45° field of view; image size 1932x1910; CFP.
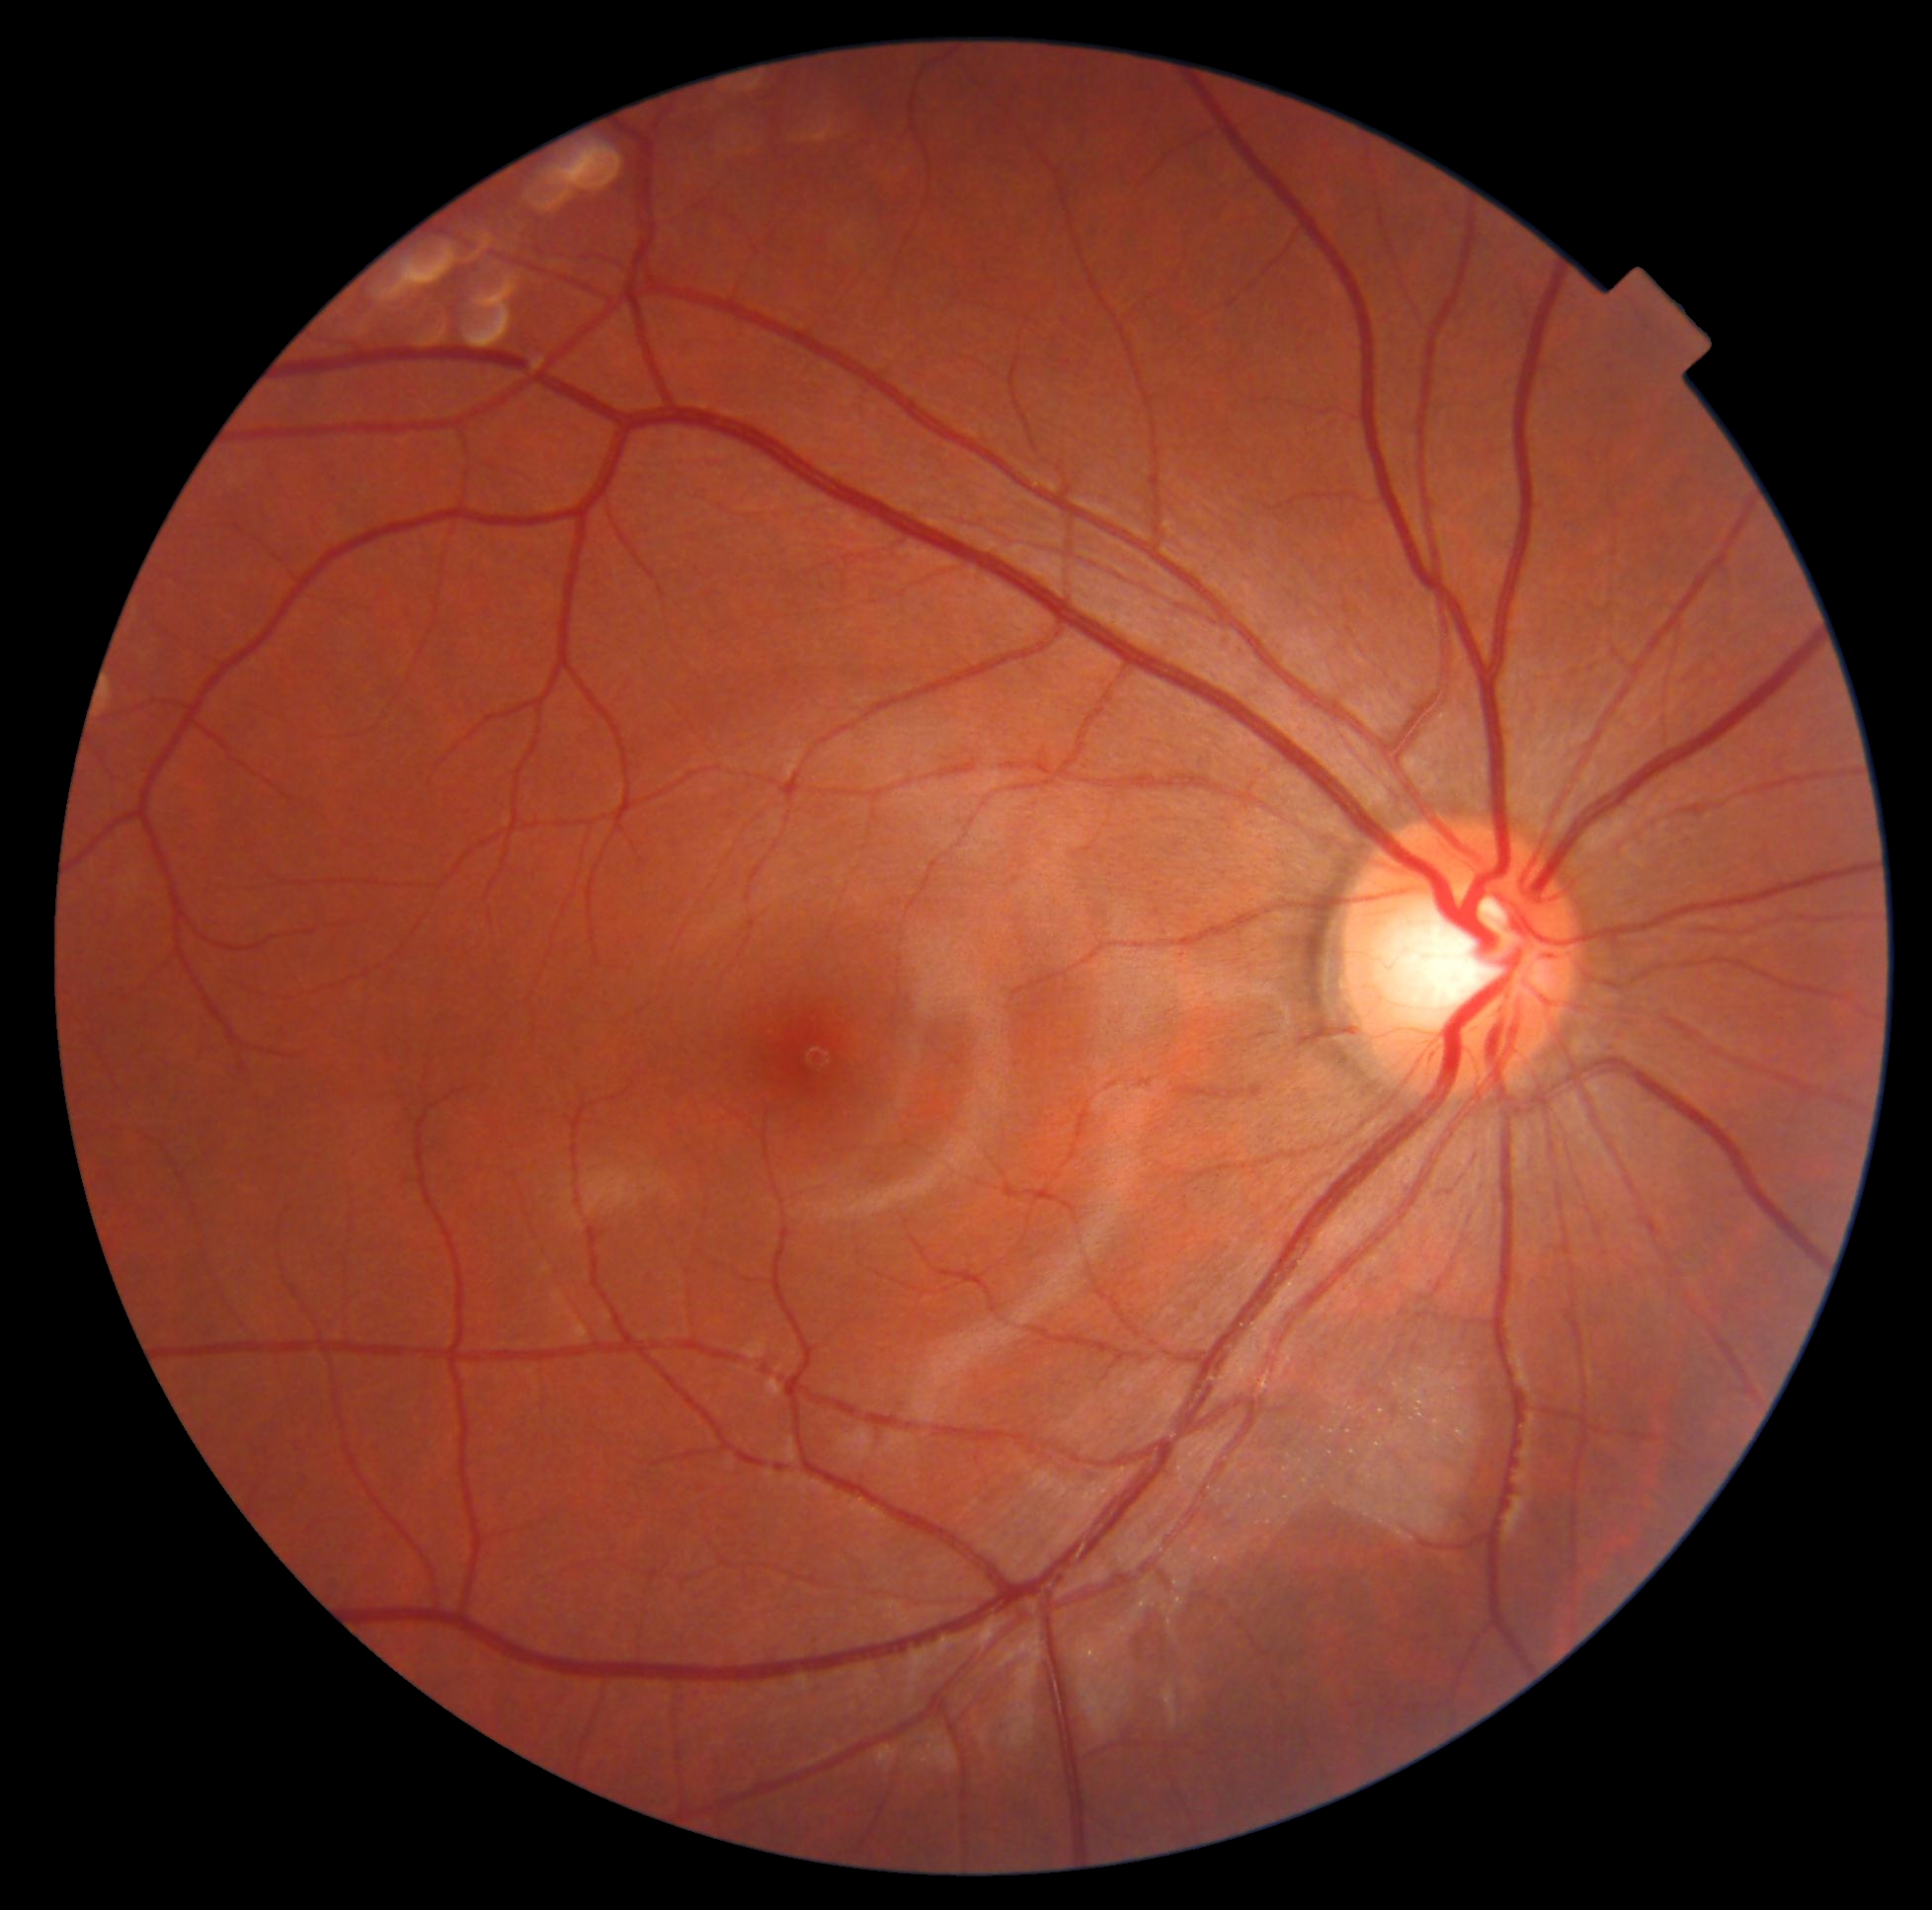

No signs of diabetic retinopathy. DR stage: grade 0 (no apparent retinopathy) — no visible signs of diabetic retinopathy.